Image size 2184x1690; fundus photo — 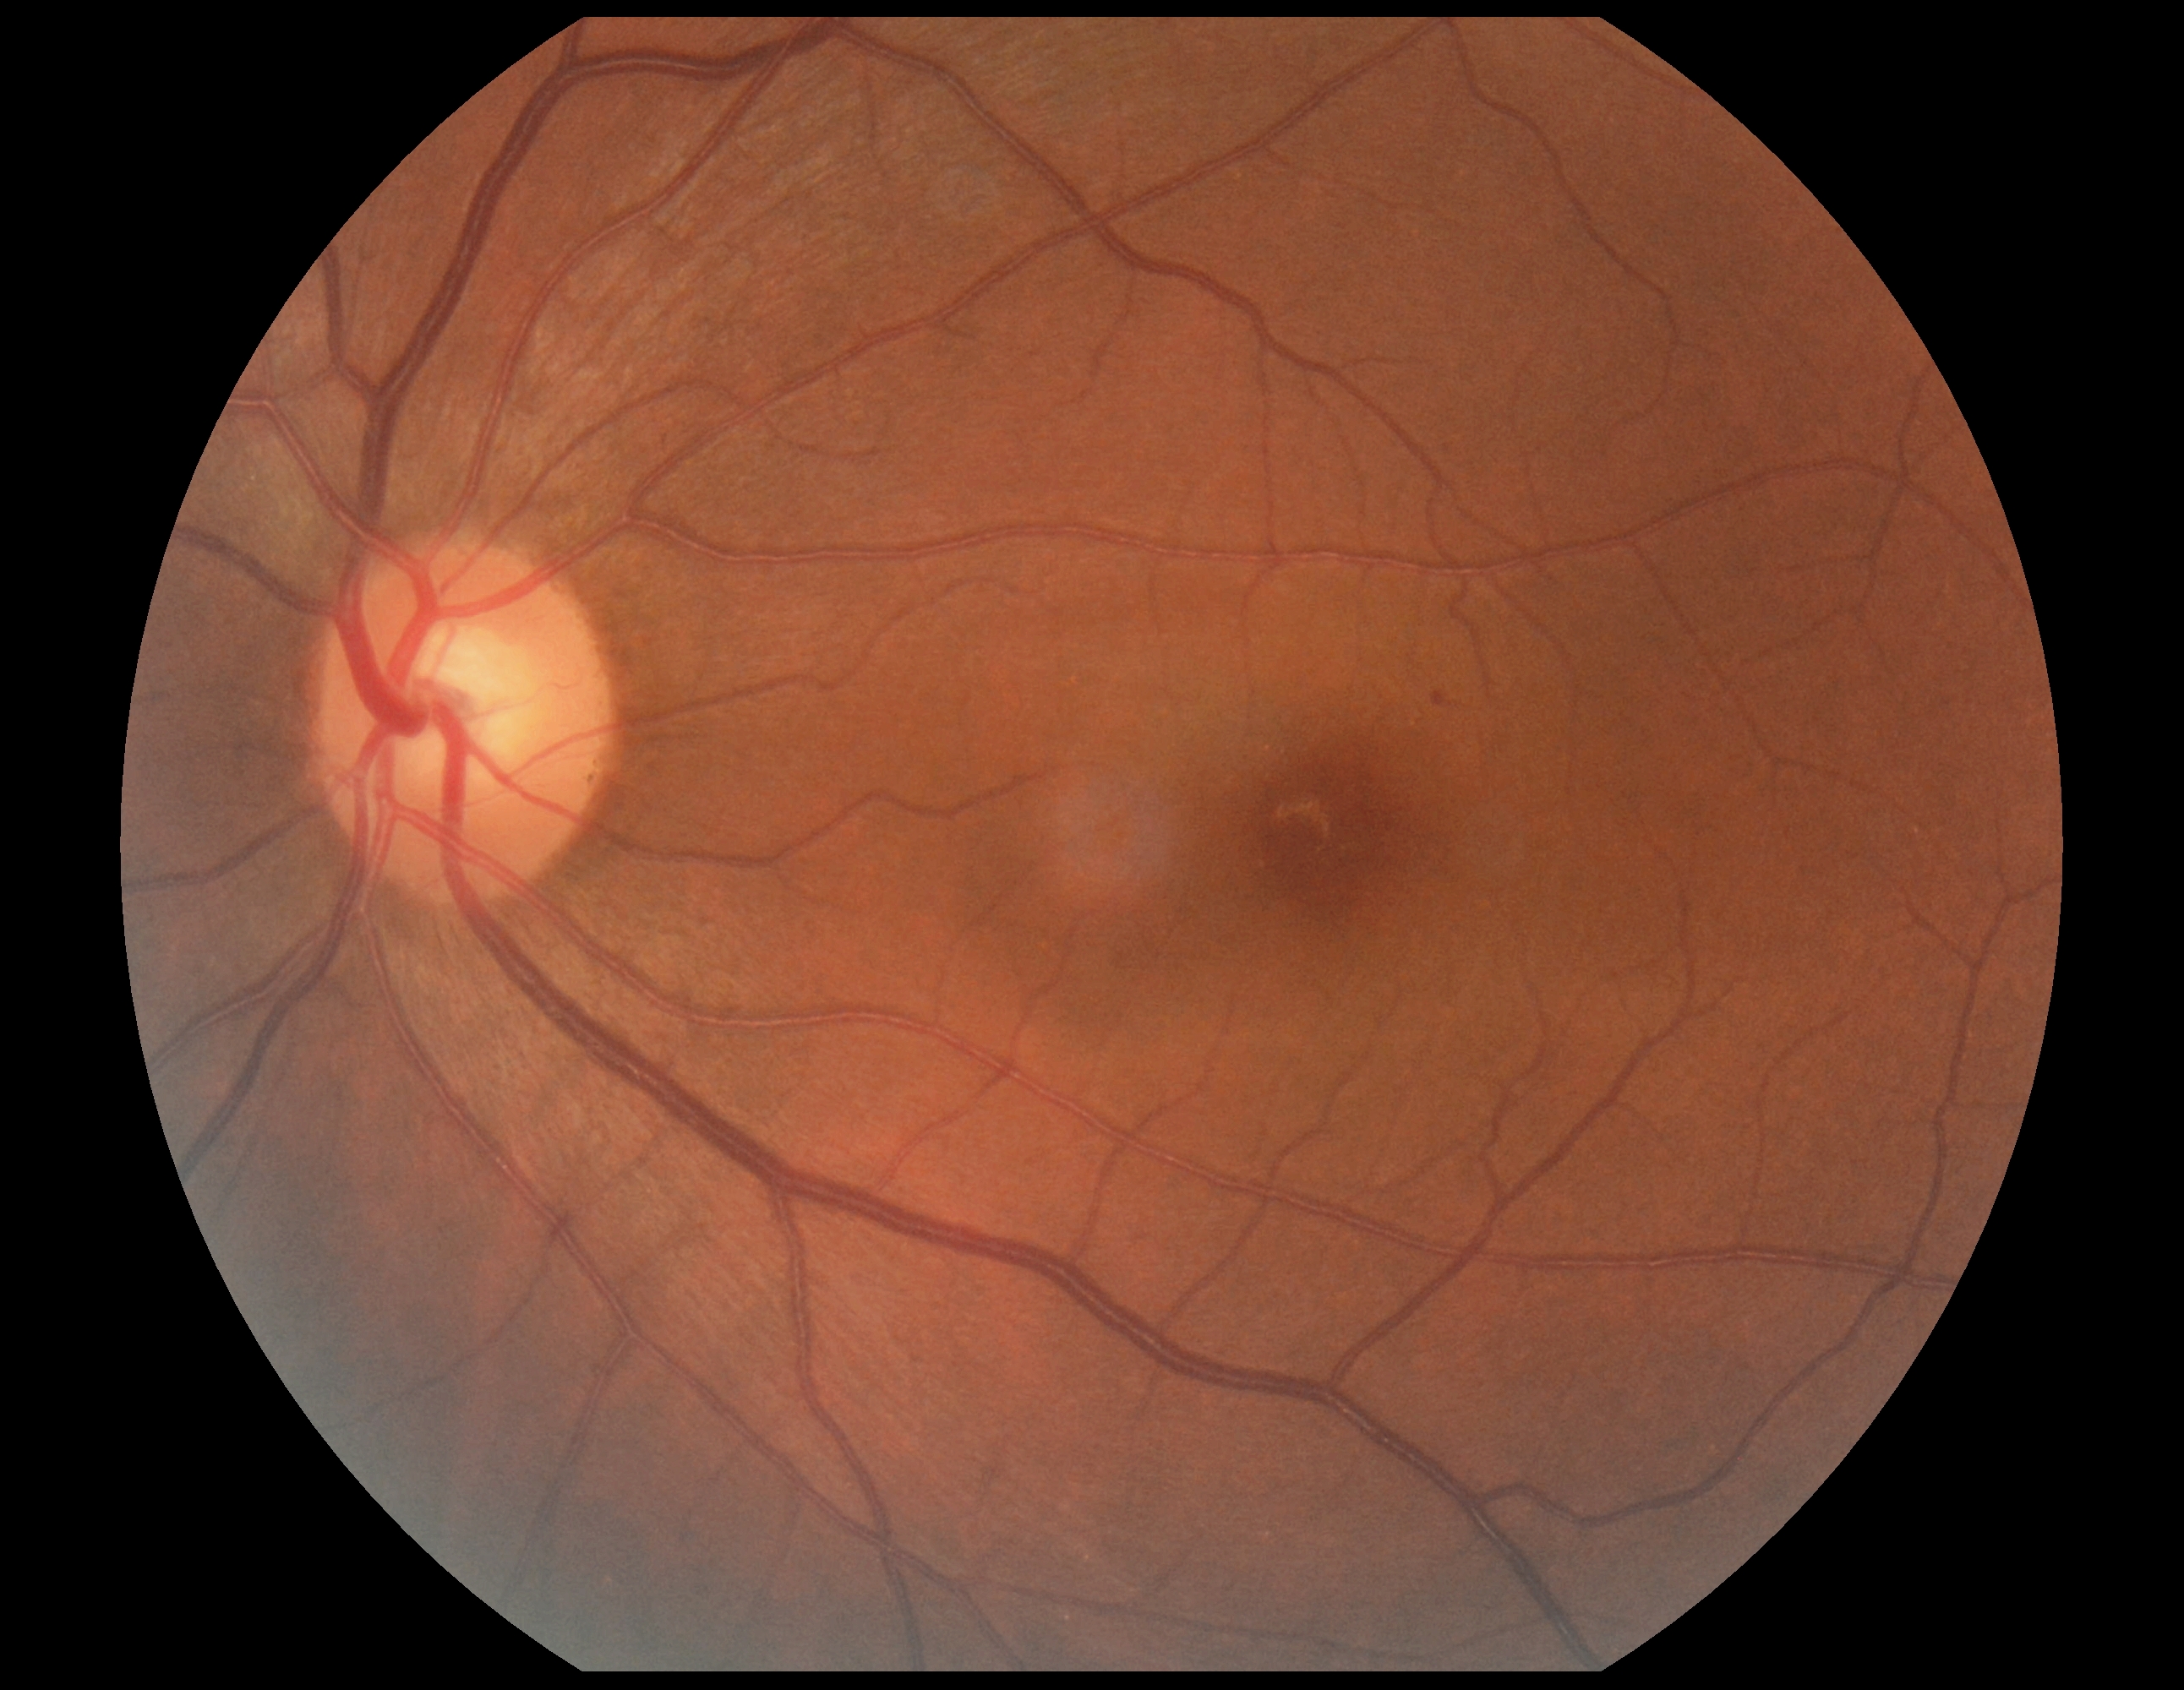
Retinopathy: grade 1 (mild NPDR).